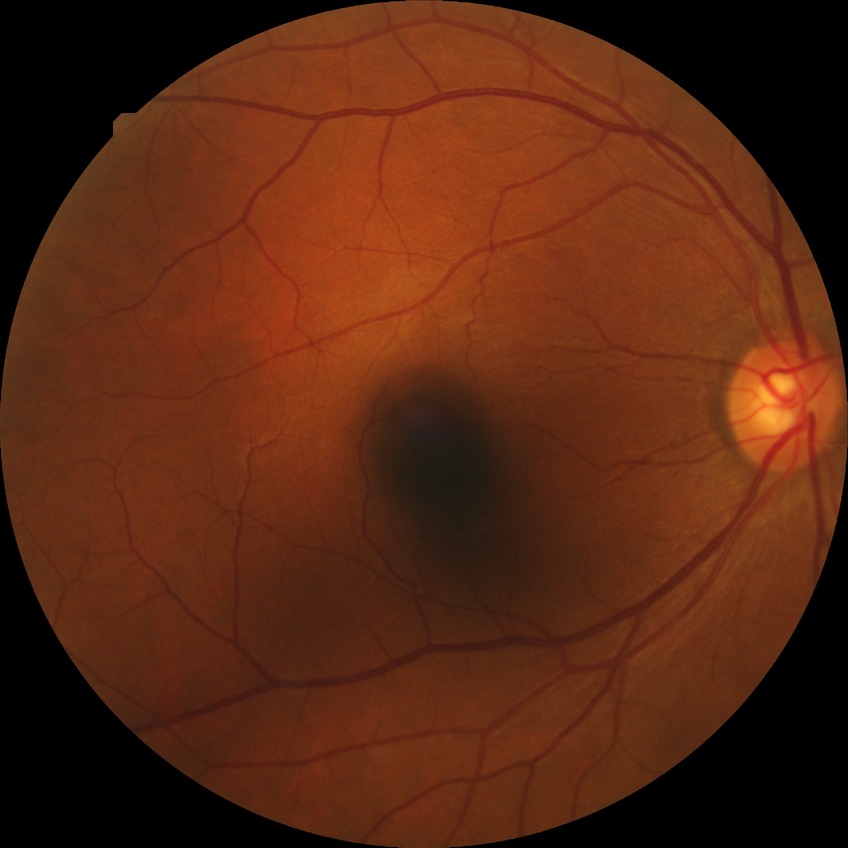
Davis stage is NDR. No signs of diabetic retinopathy.